2212 x 1659 pixels.
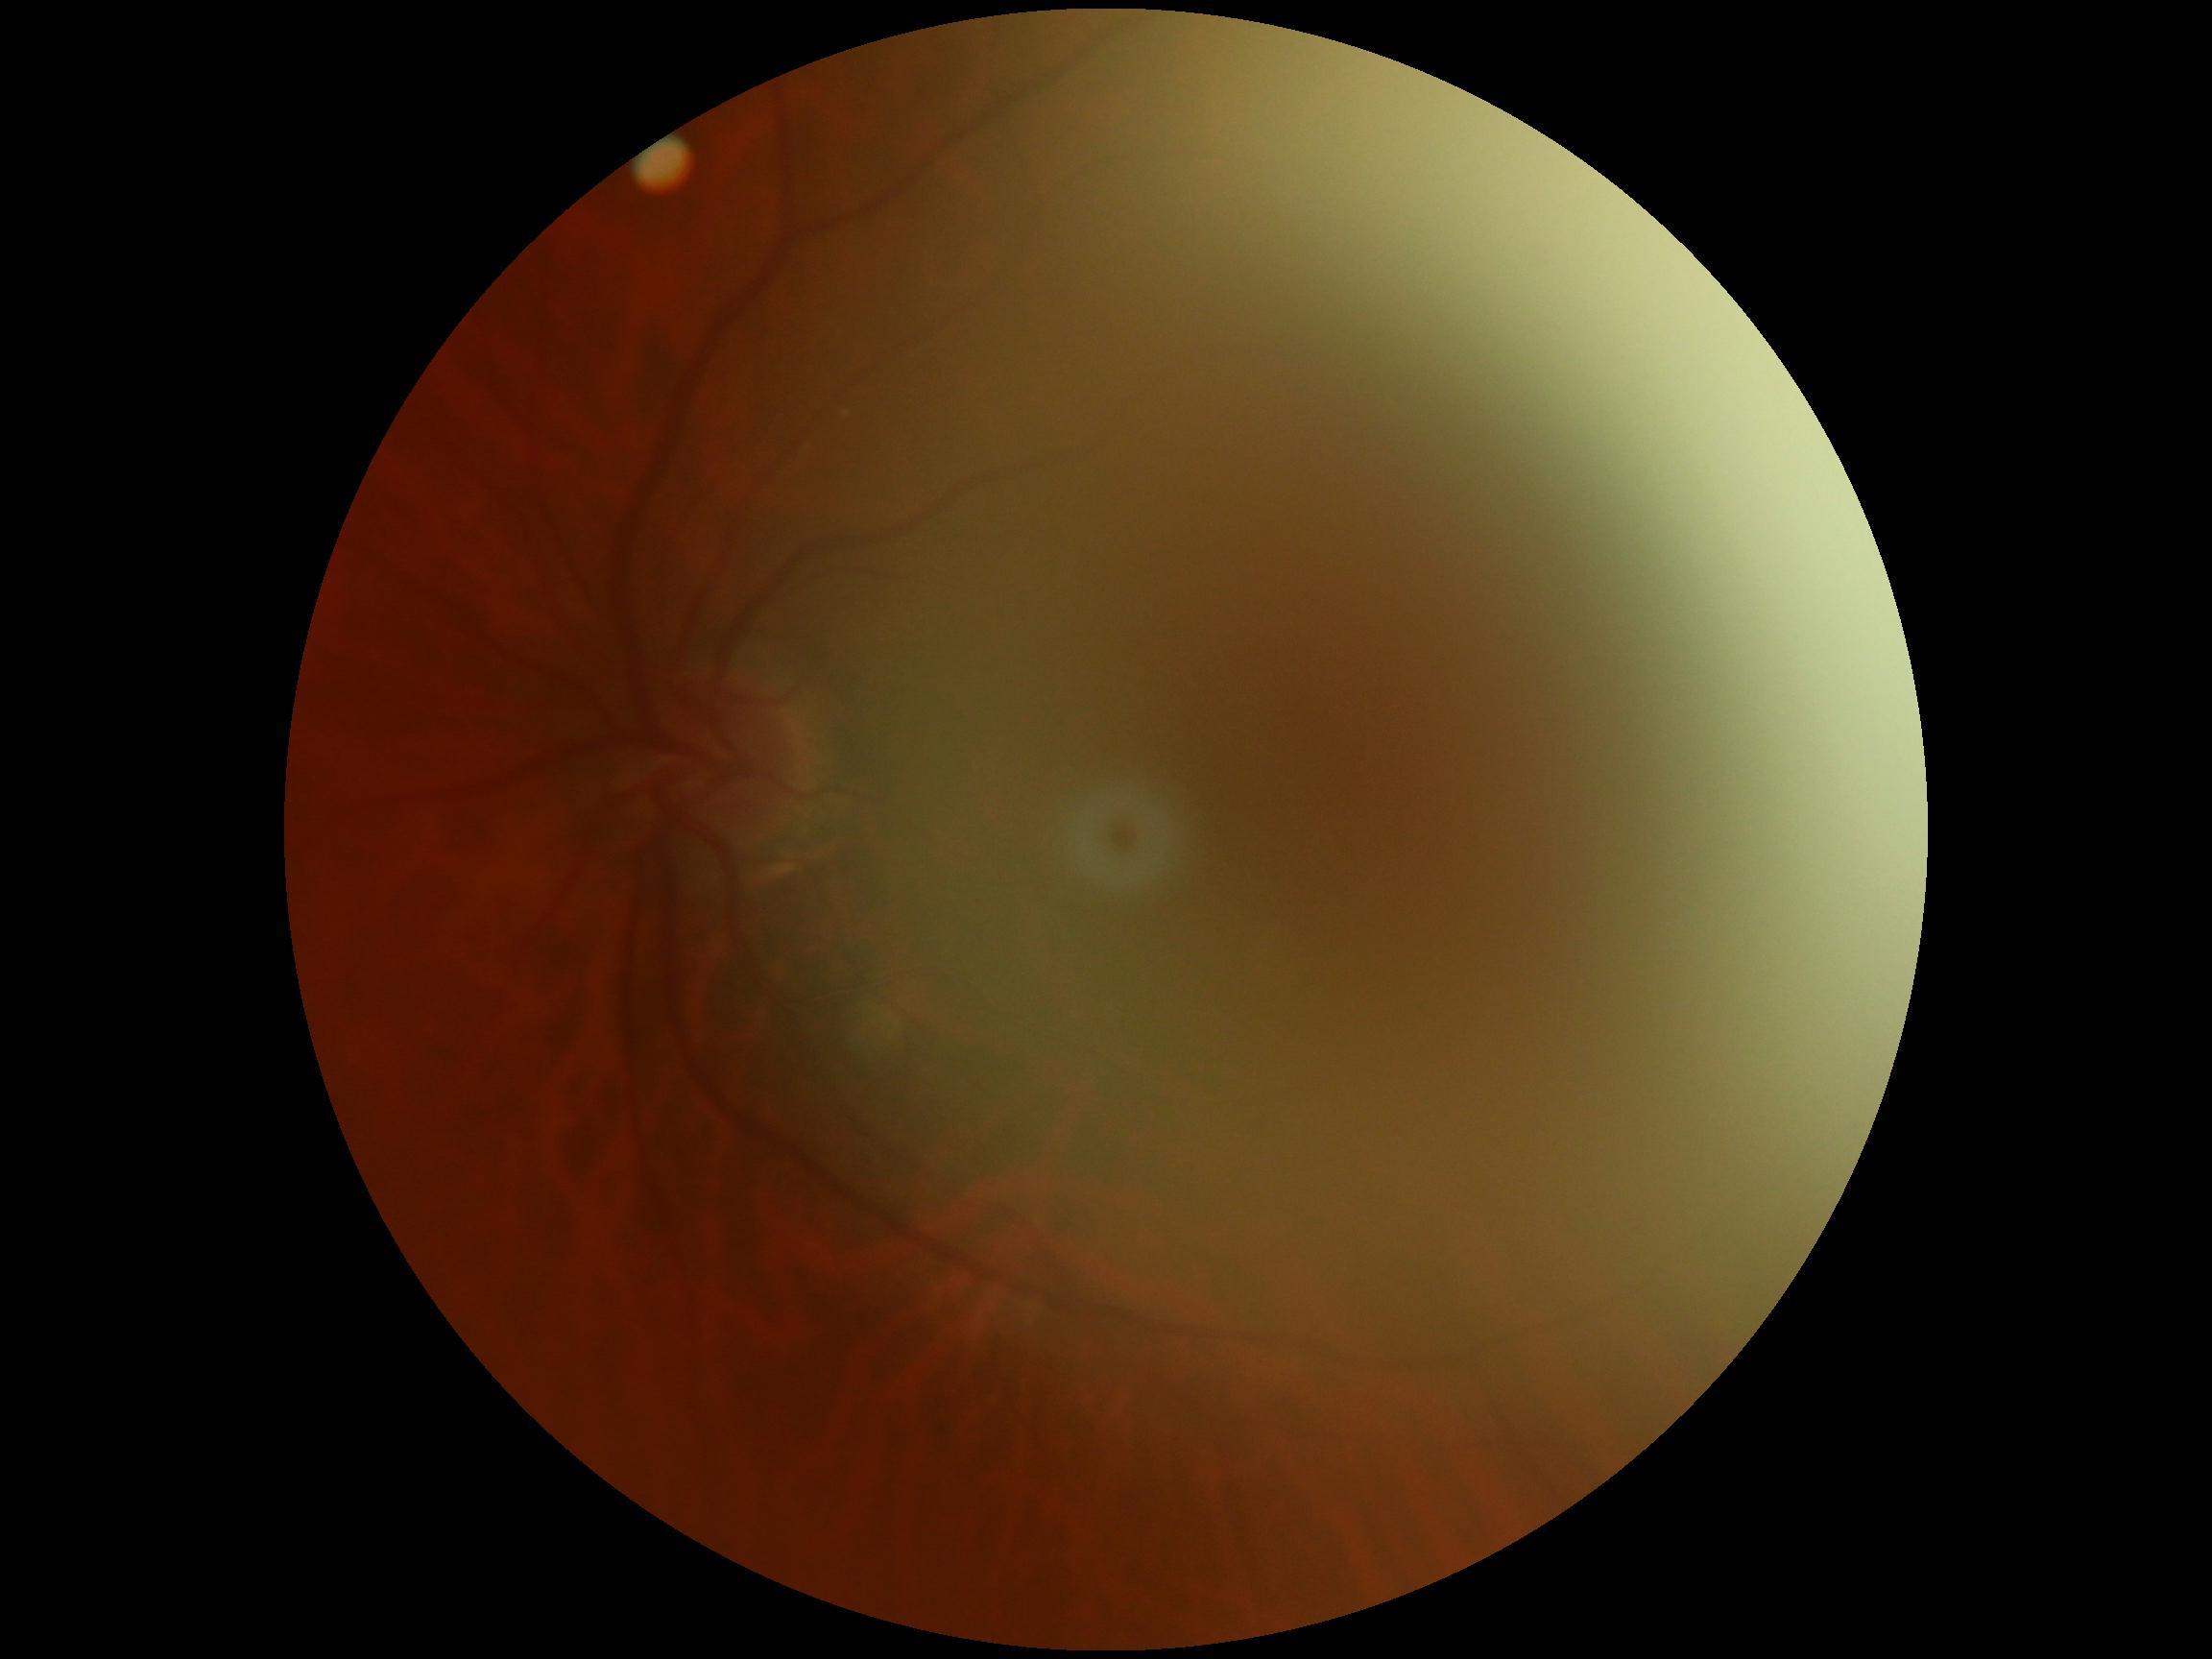

DR stage: ungradable.